848x848px. Nonmydriatic fundus photograph. Fundus photo: 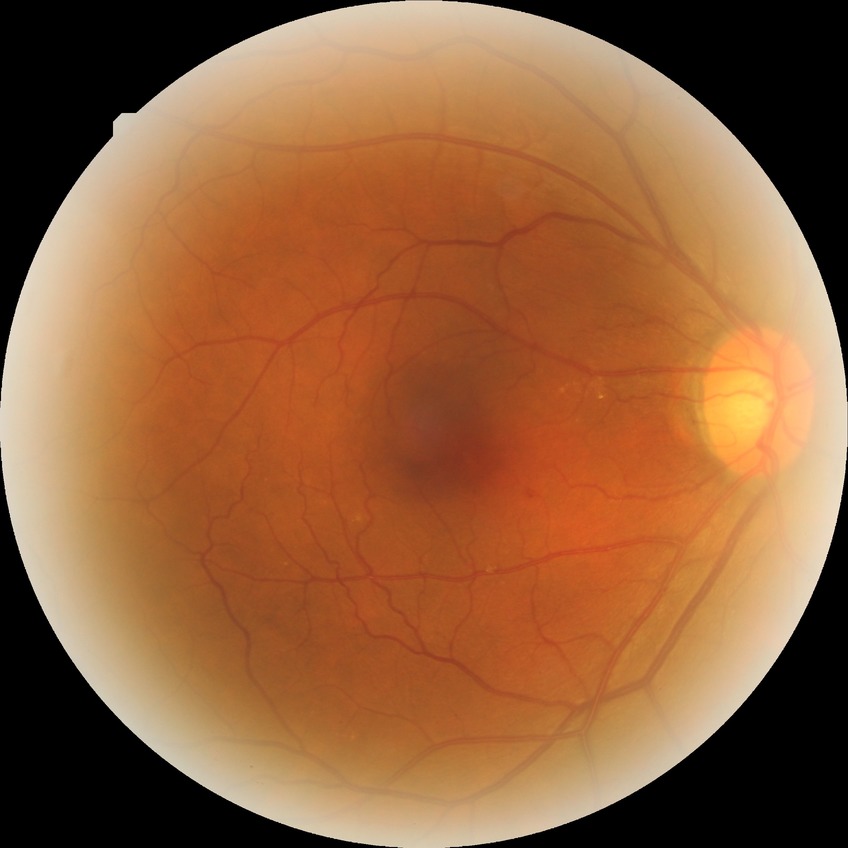
Davis DR grade is SDR.